Camera: Kowa VX-10α · centered on the macula — 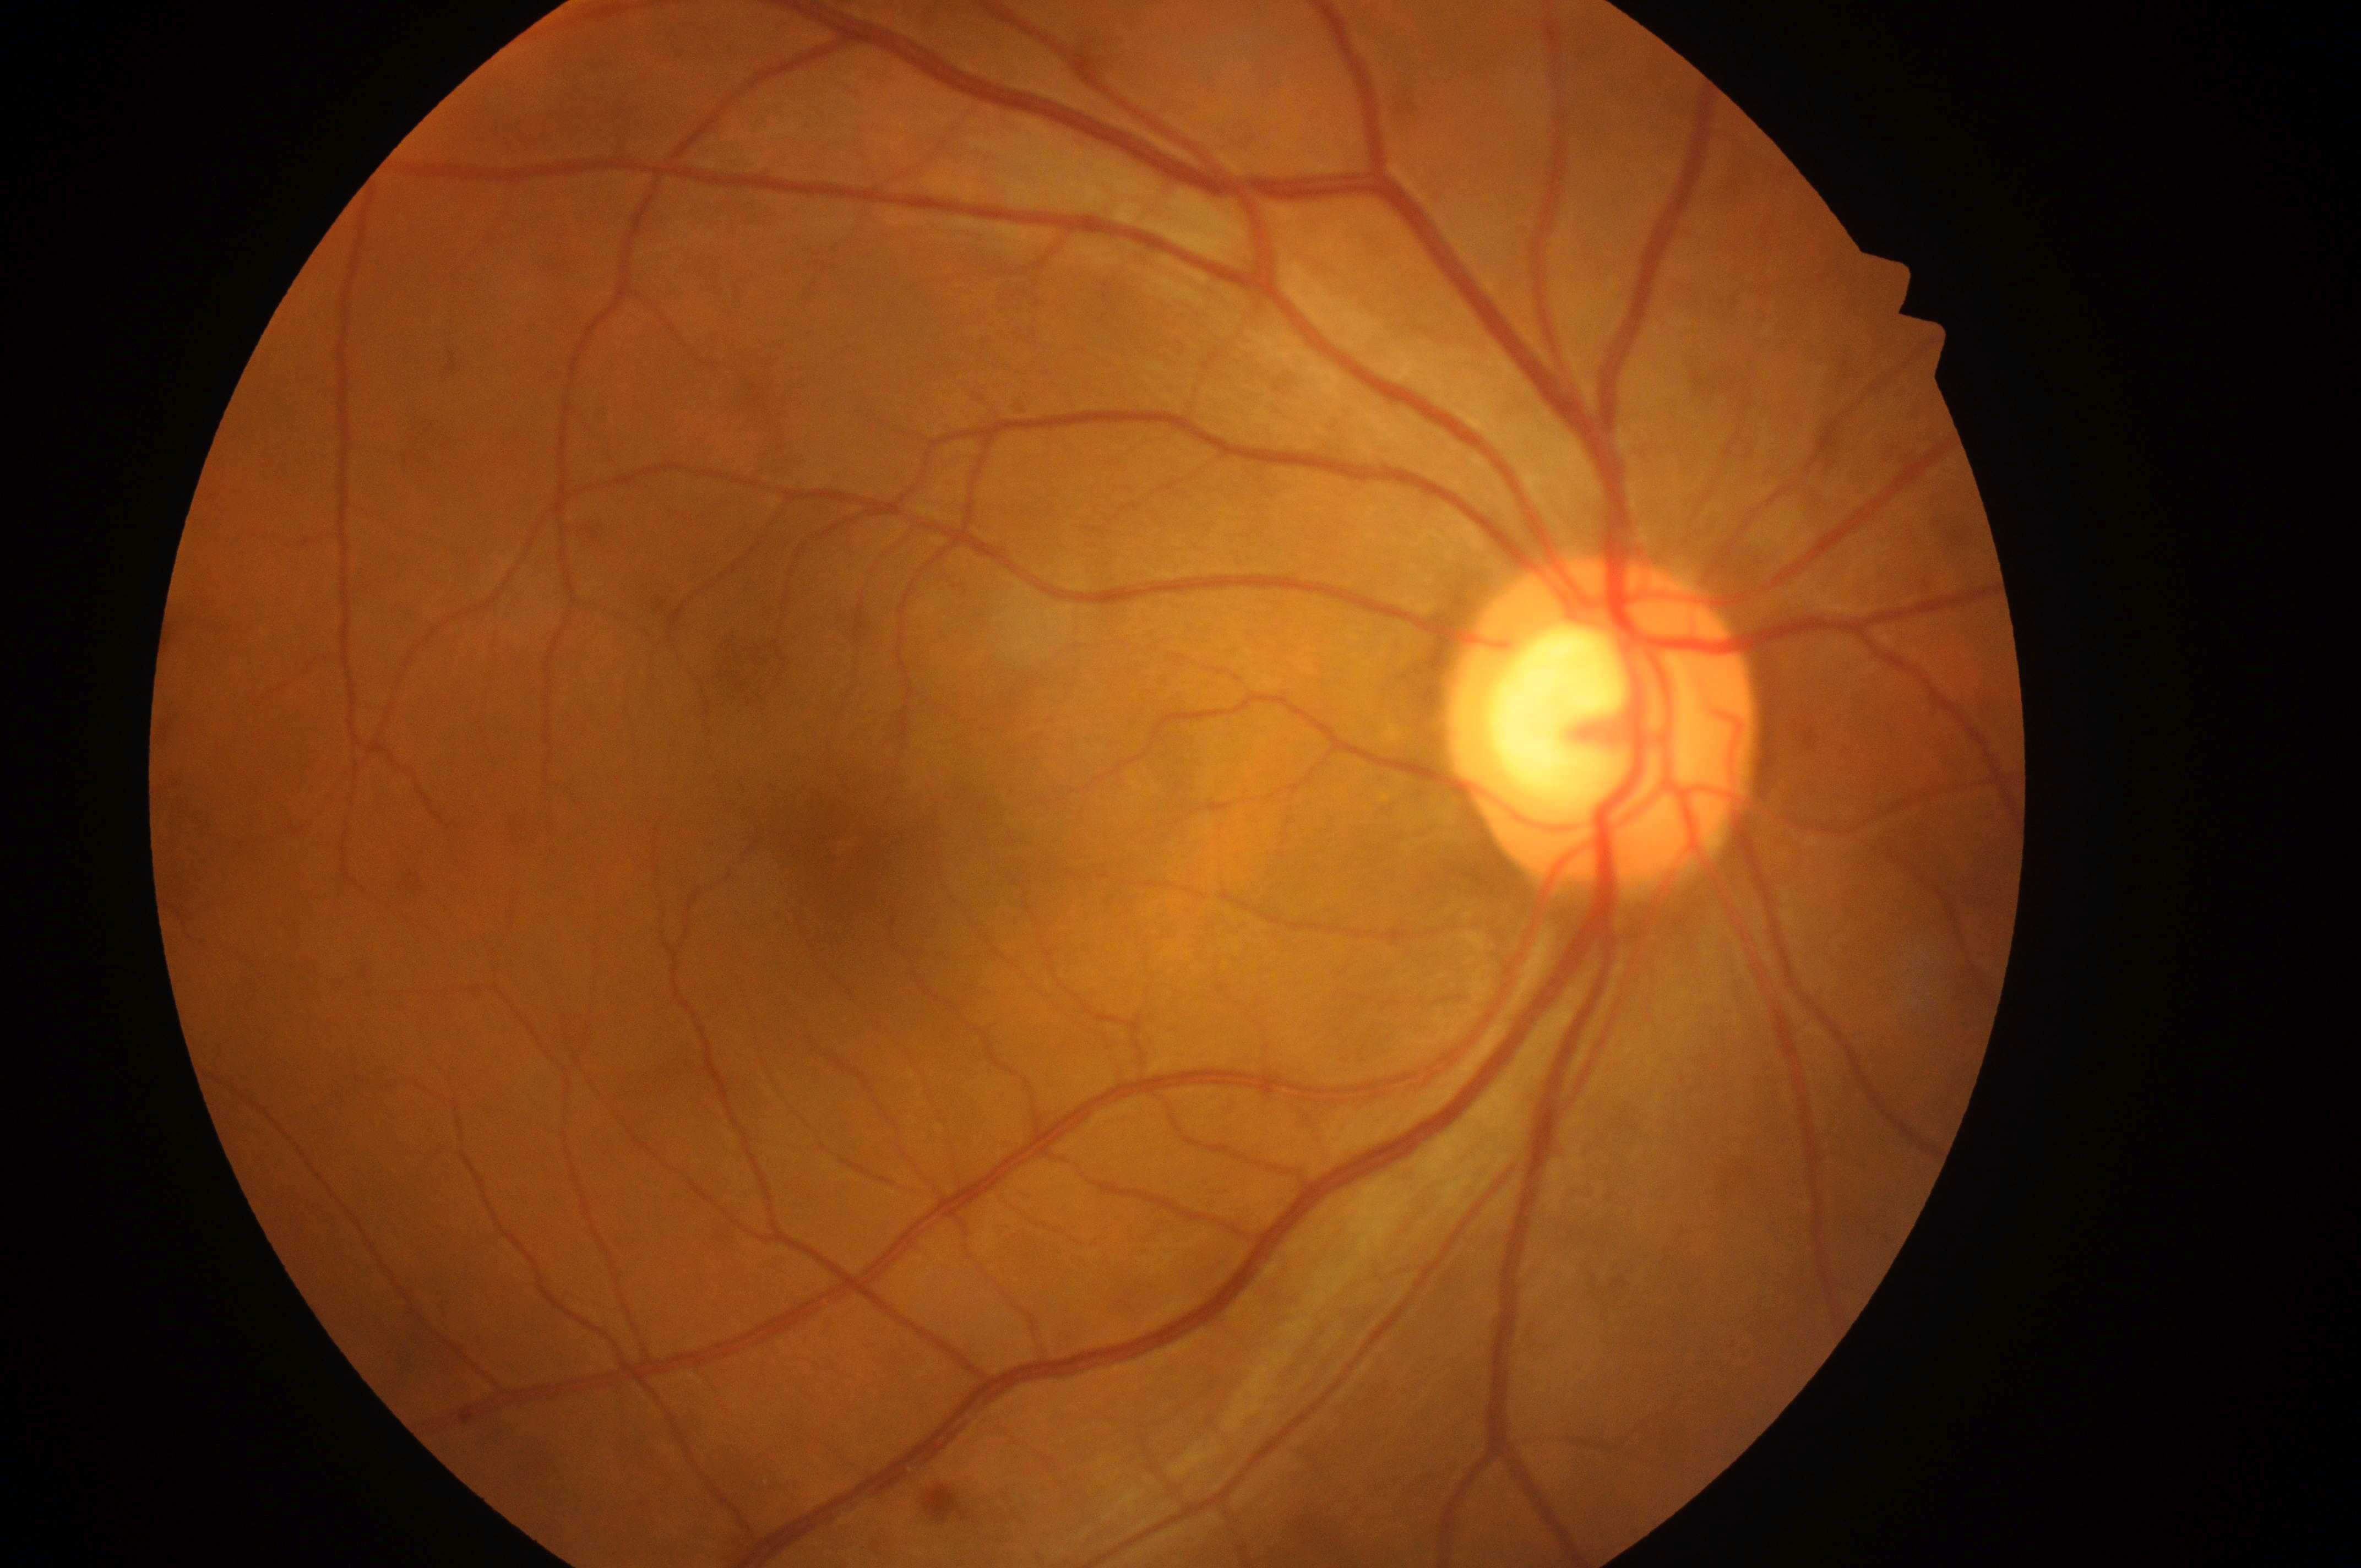 eye: right eye
dme_grade: 0
fovea: (852,850)
optic_disc: (1601,734)
dr_grade: 0